Color fundus photograph, 2089 by 1764 pixels.
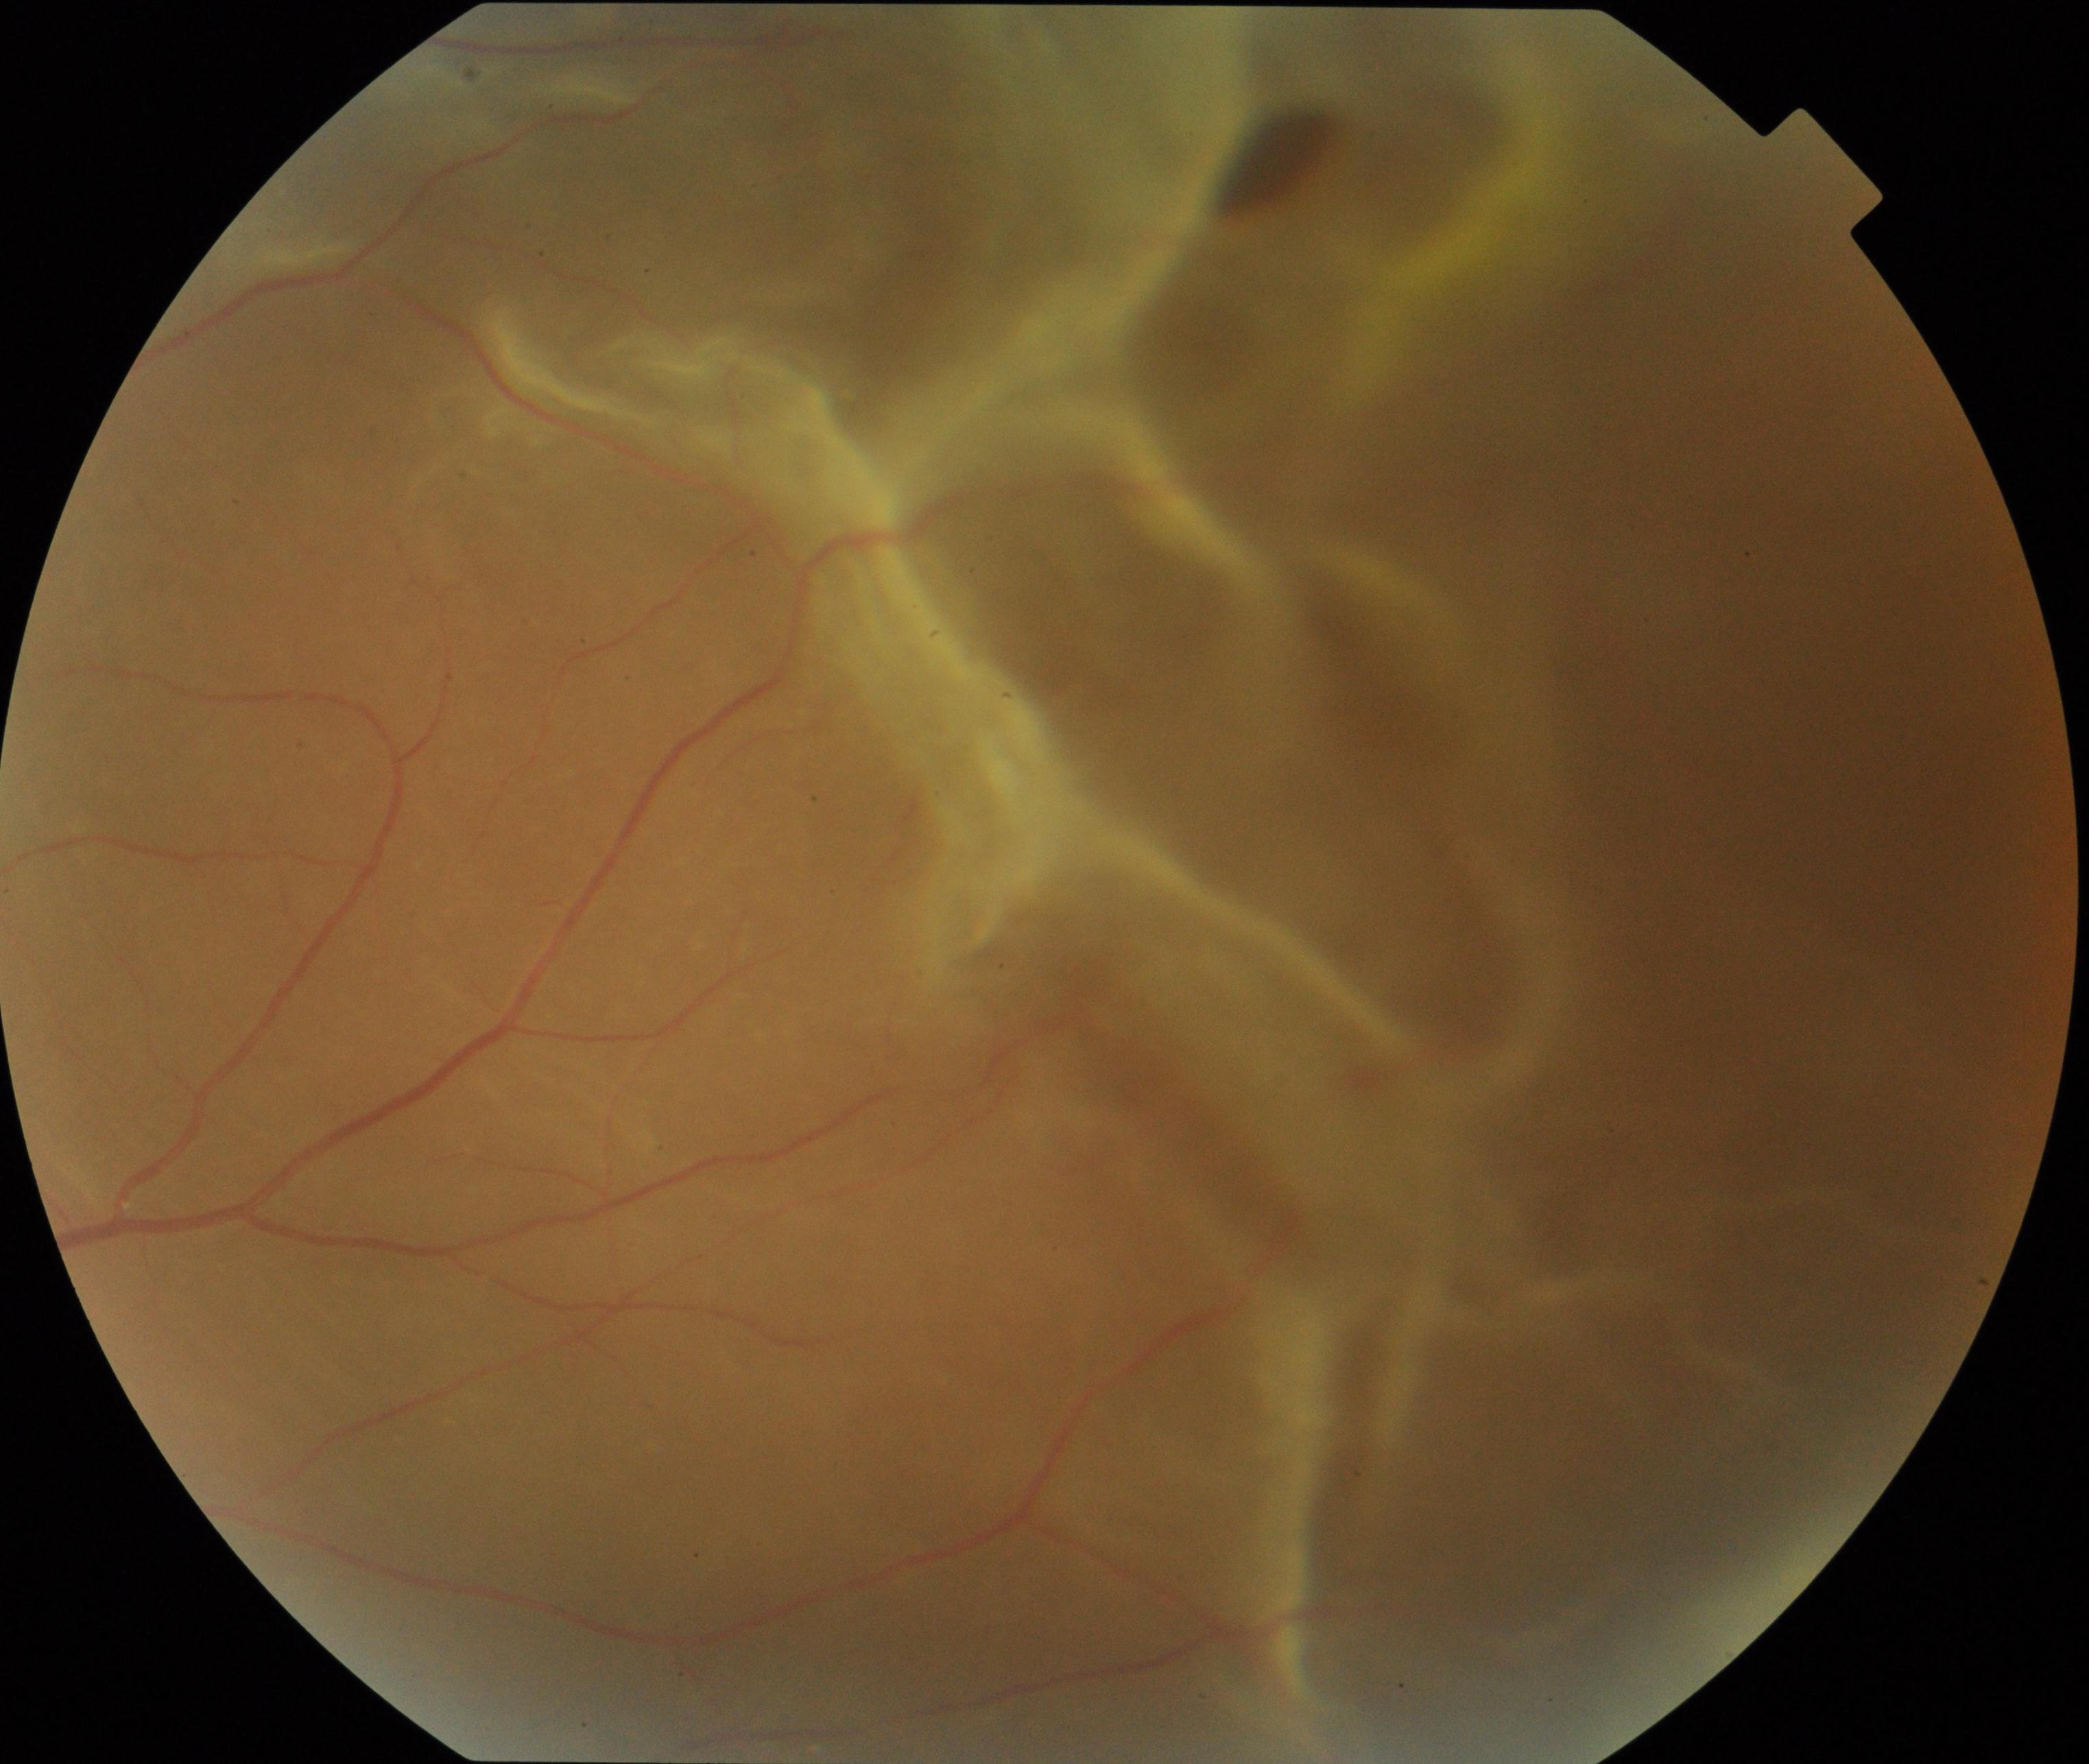
Findings consistent with rhegmatogenous retinal detachment.